Image size 2048x1536: 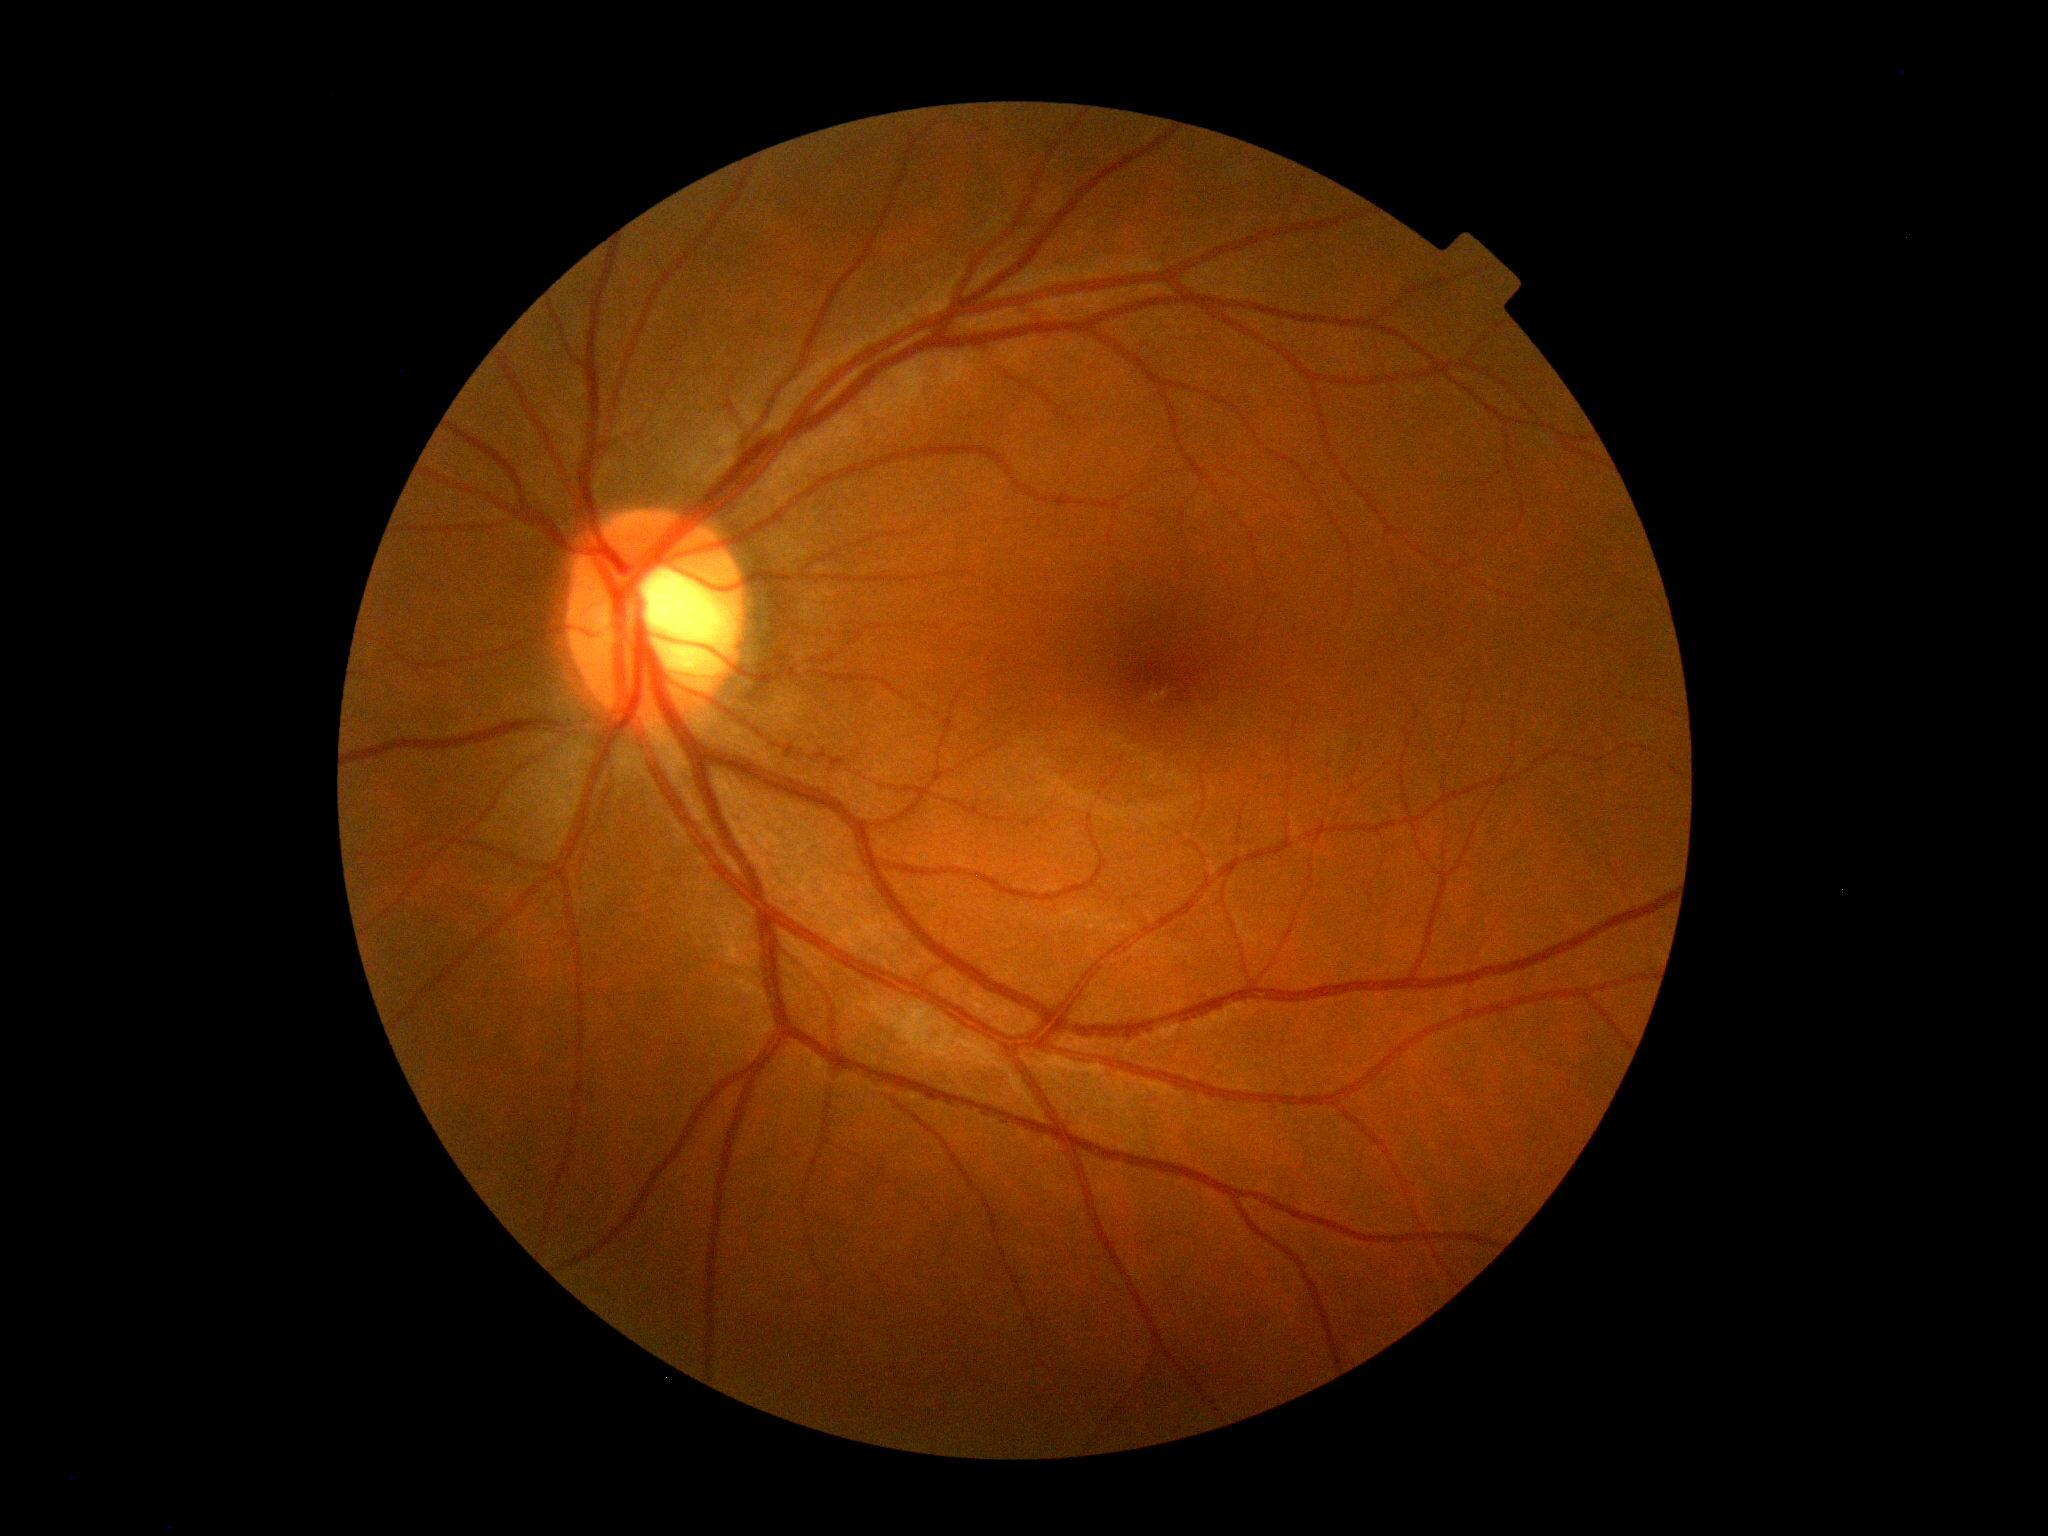   dr_grade: grade 0 (no apparent retinopathy)